1440 x 1080 pixels · infant wide-field retinal image.
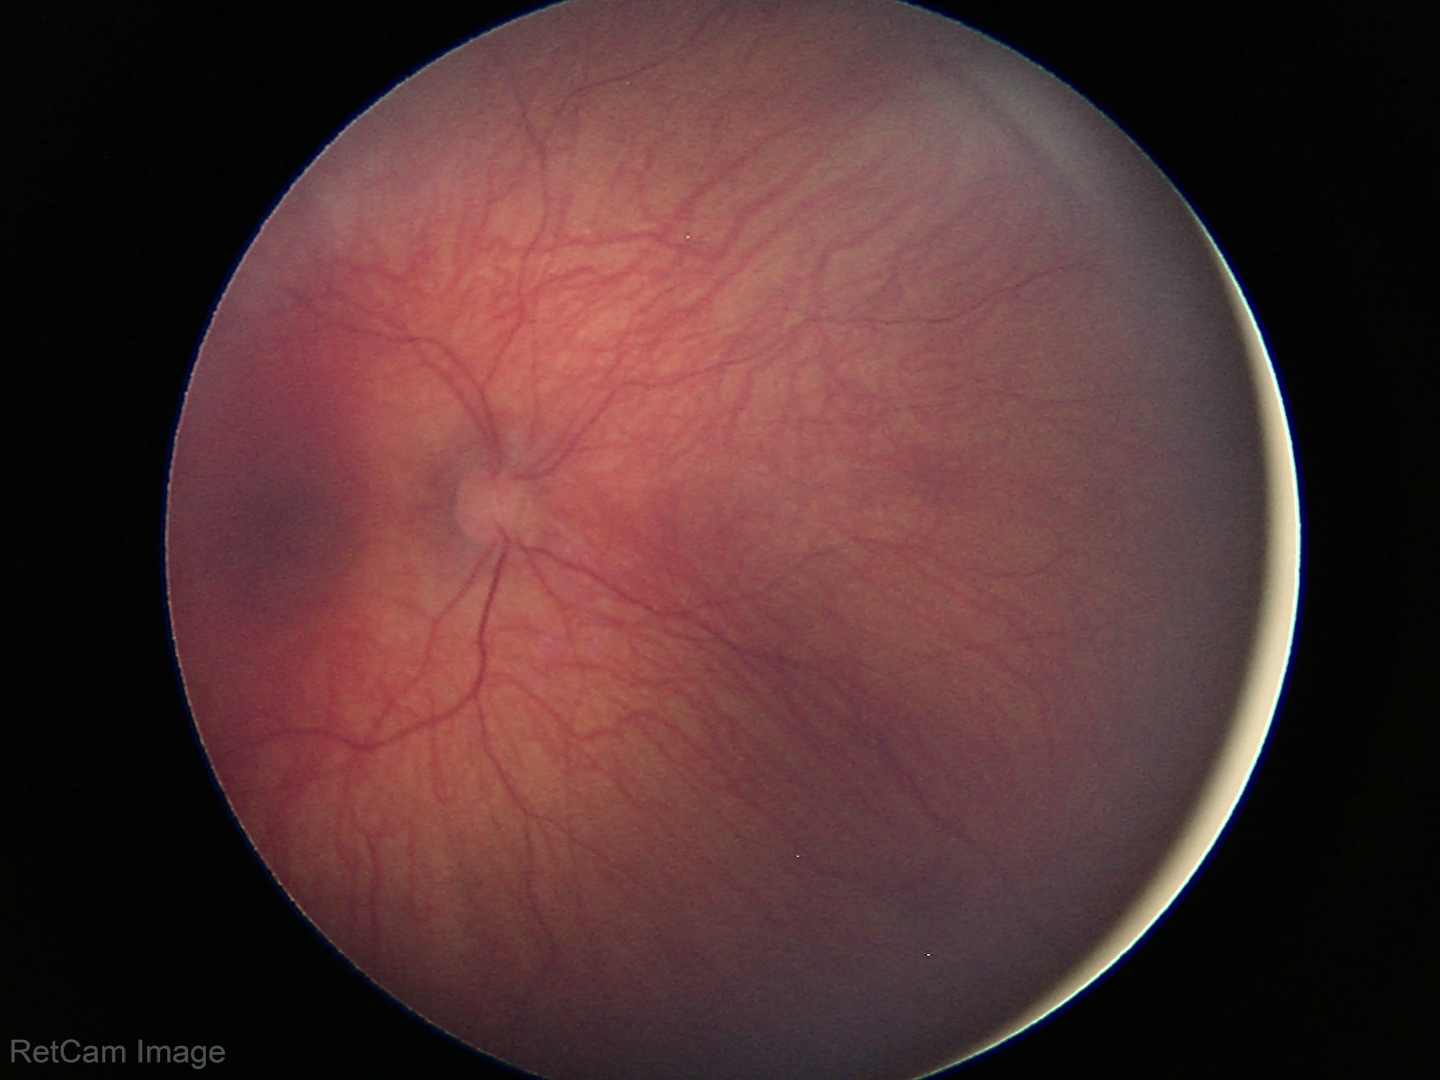
Examination with physiological retinal findings.